Fundus photo — 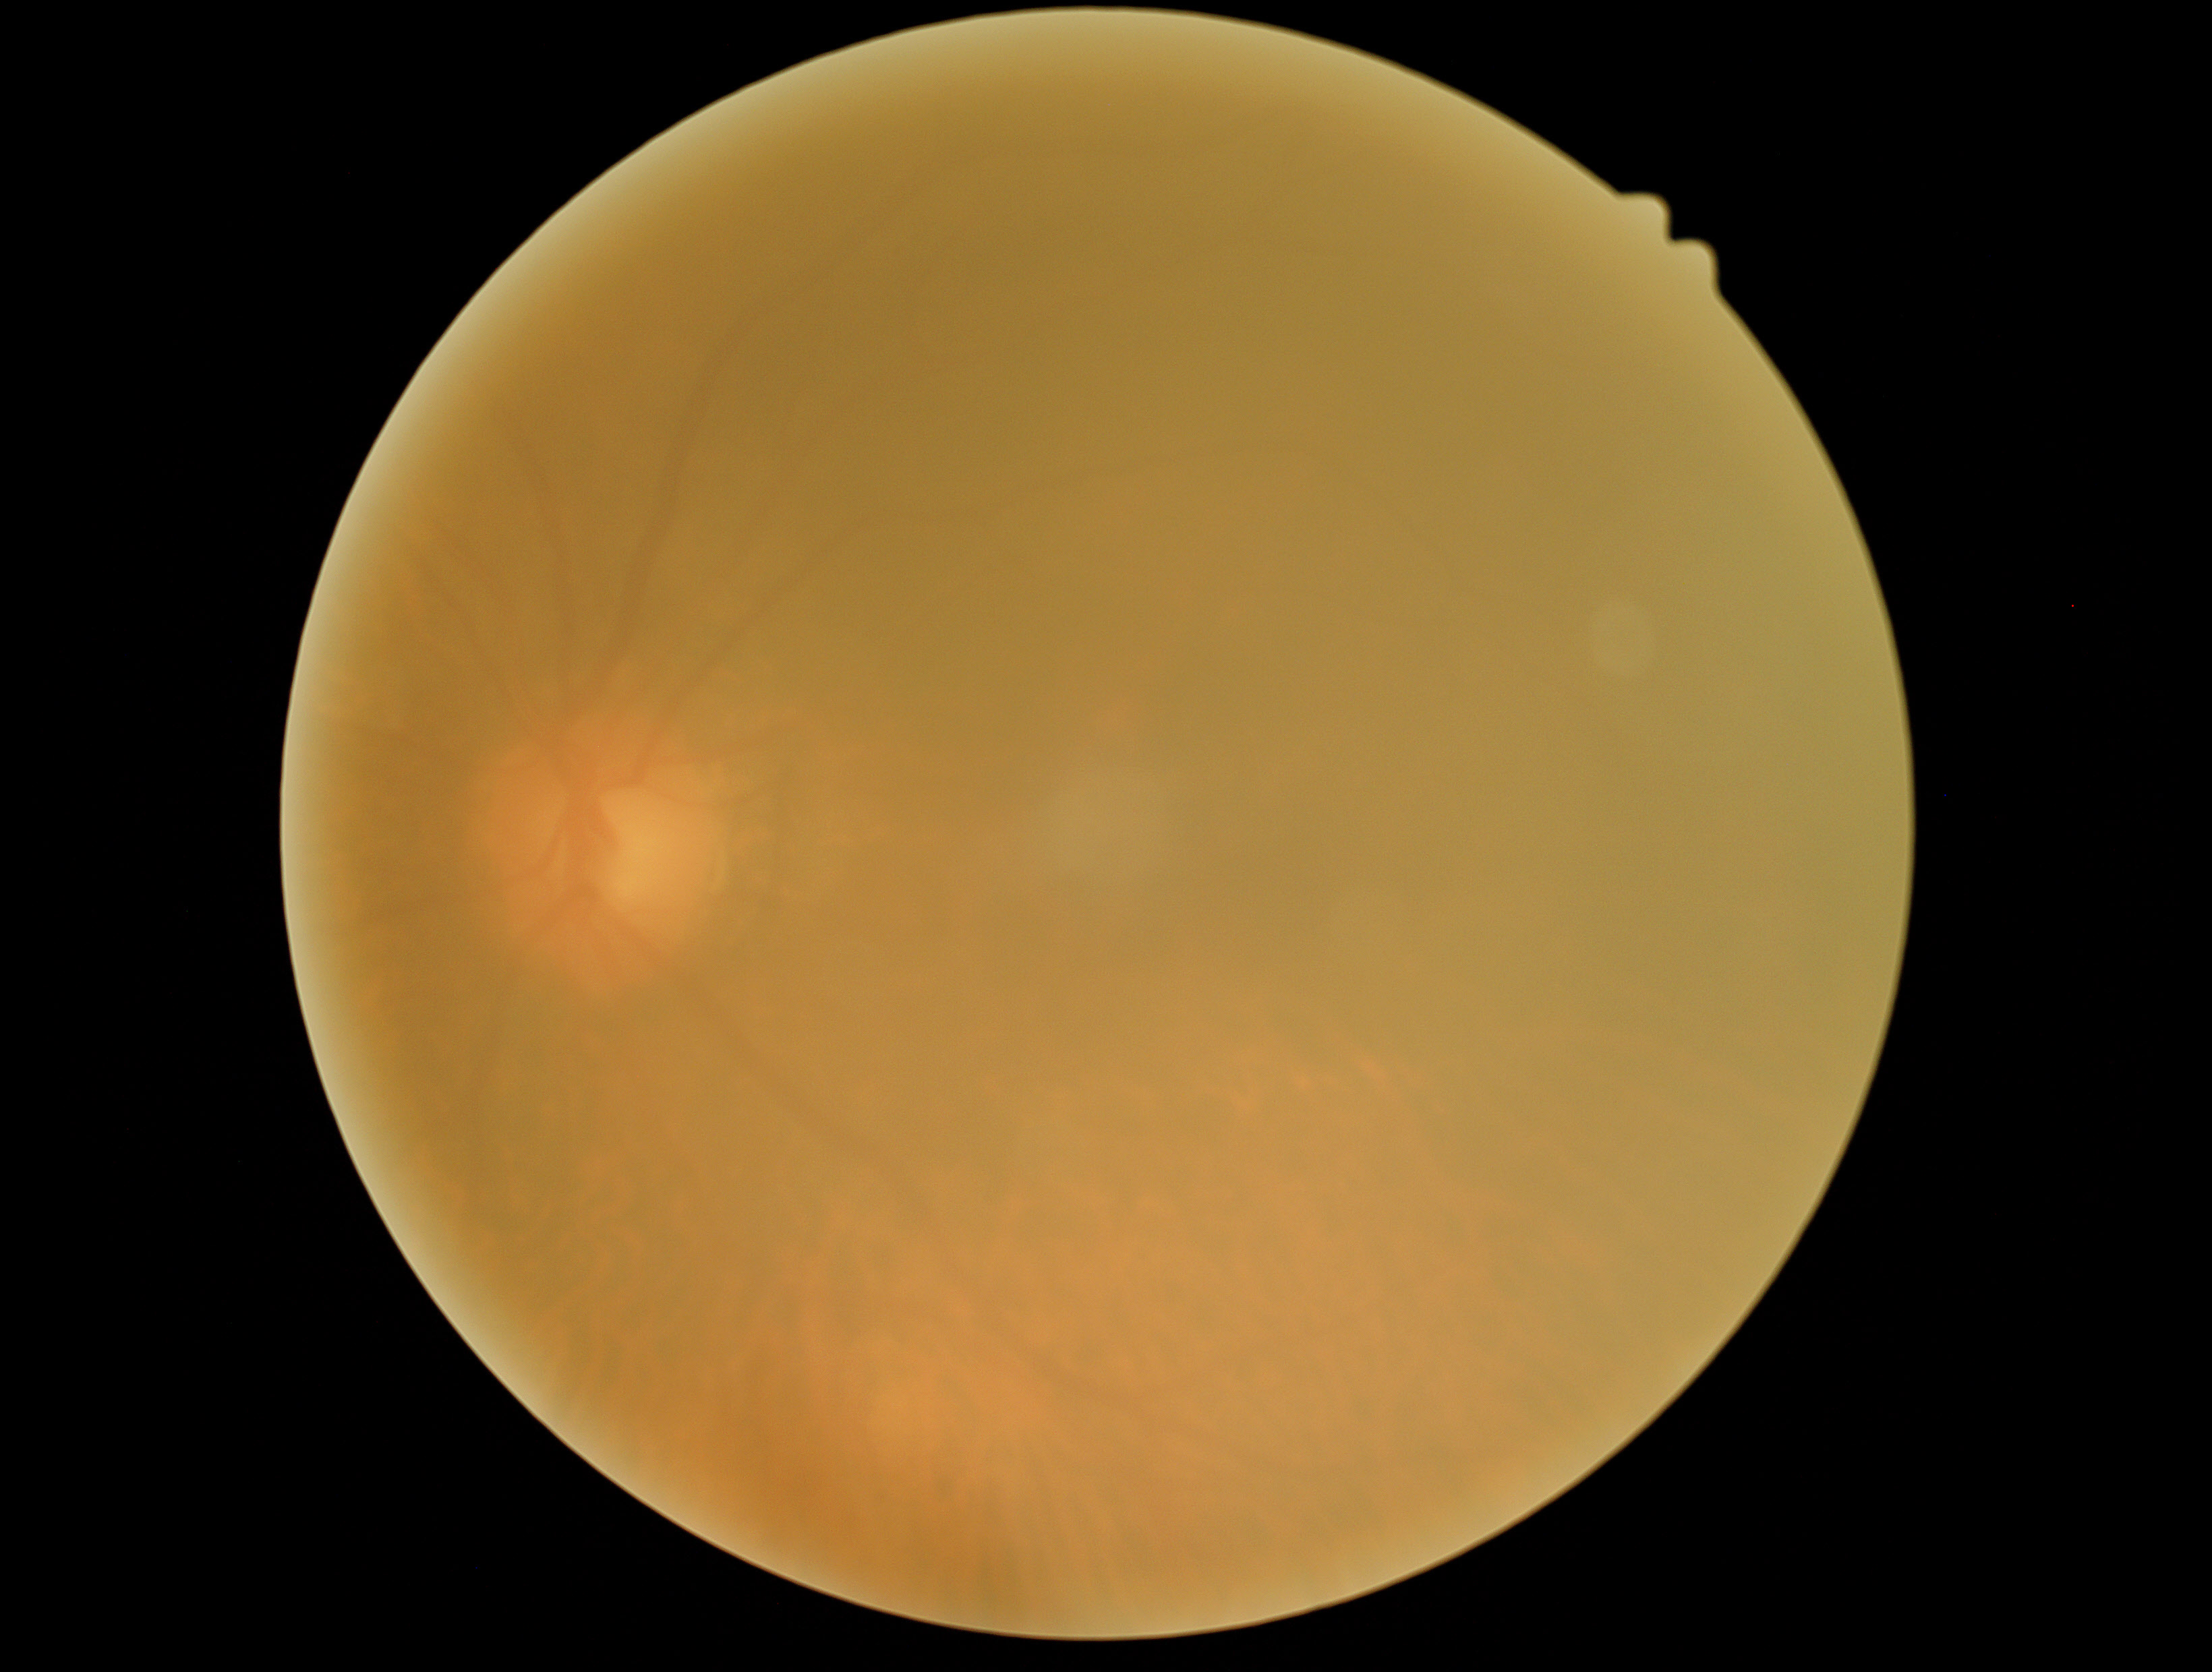

DR severity: 0.